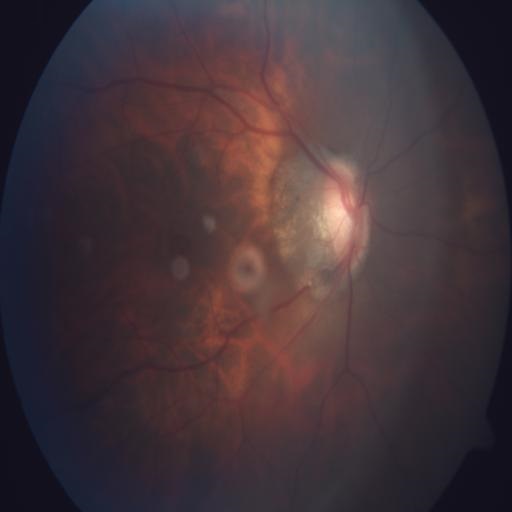 Diagnosis: tilted disc.